Camera: NIDEK AFC-230; no pharmacologic dilation.
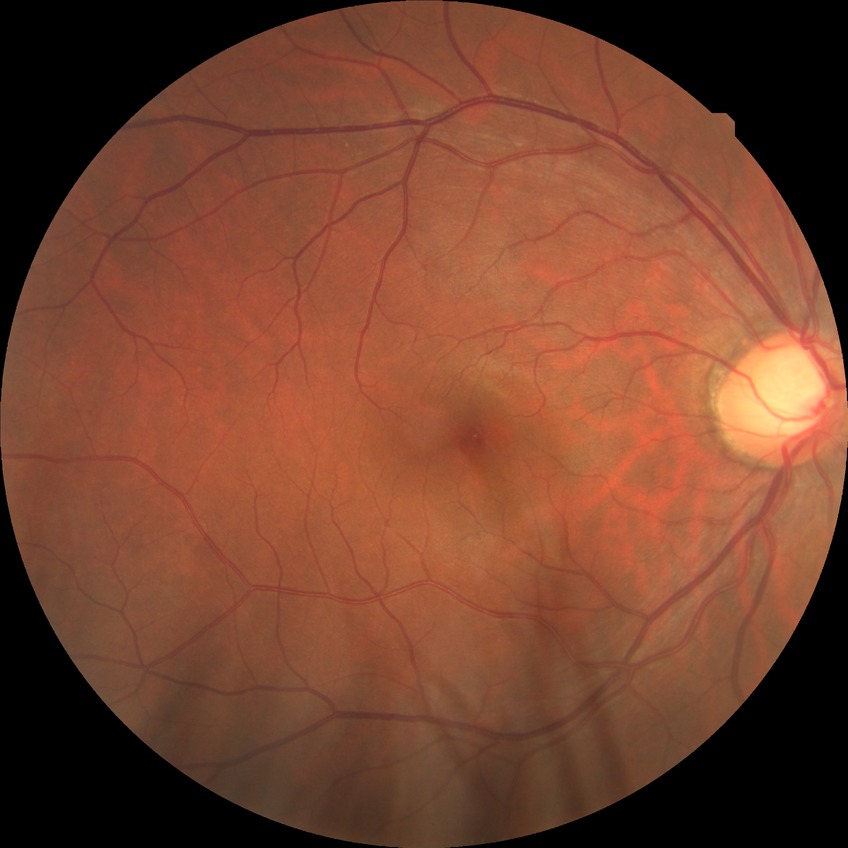

  davis_grade: NDR (no diabetic retinopathy)